Wide-field contact fundus photograph of an infant · image size 1440x1080 — 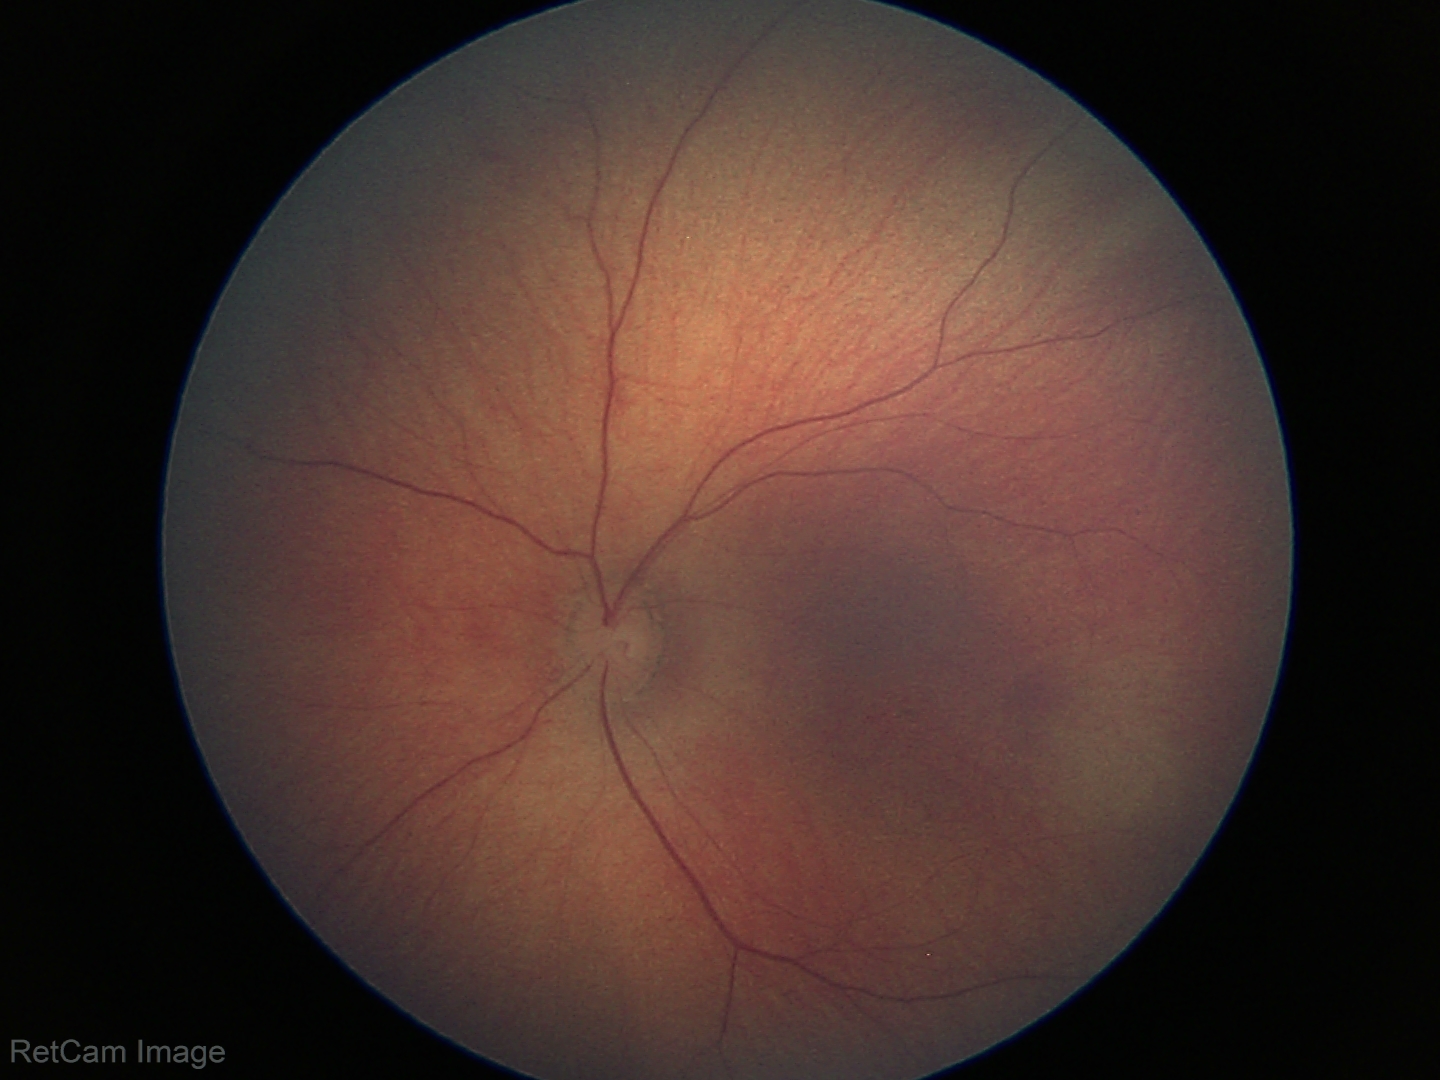
No retinal pathology identified on screening.